Phoenix ICON wide-field infant fundus image: 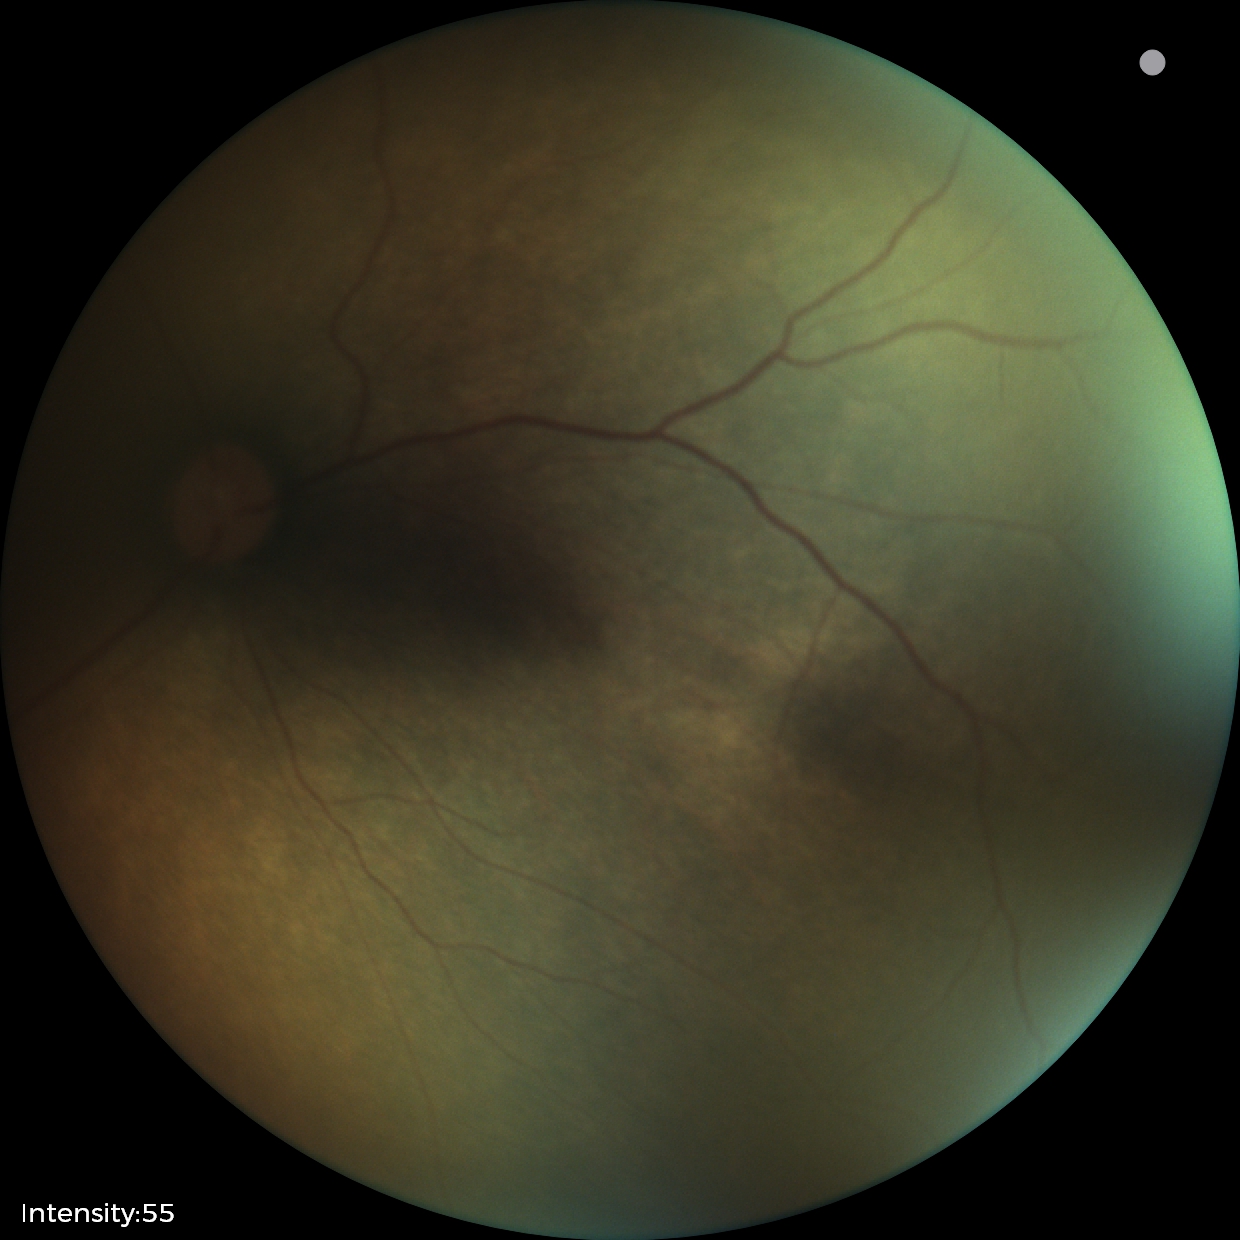

Screening series with status post retinopathy of prematurity (ROP).